Posterior pole color fundus photograph
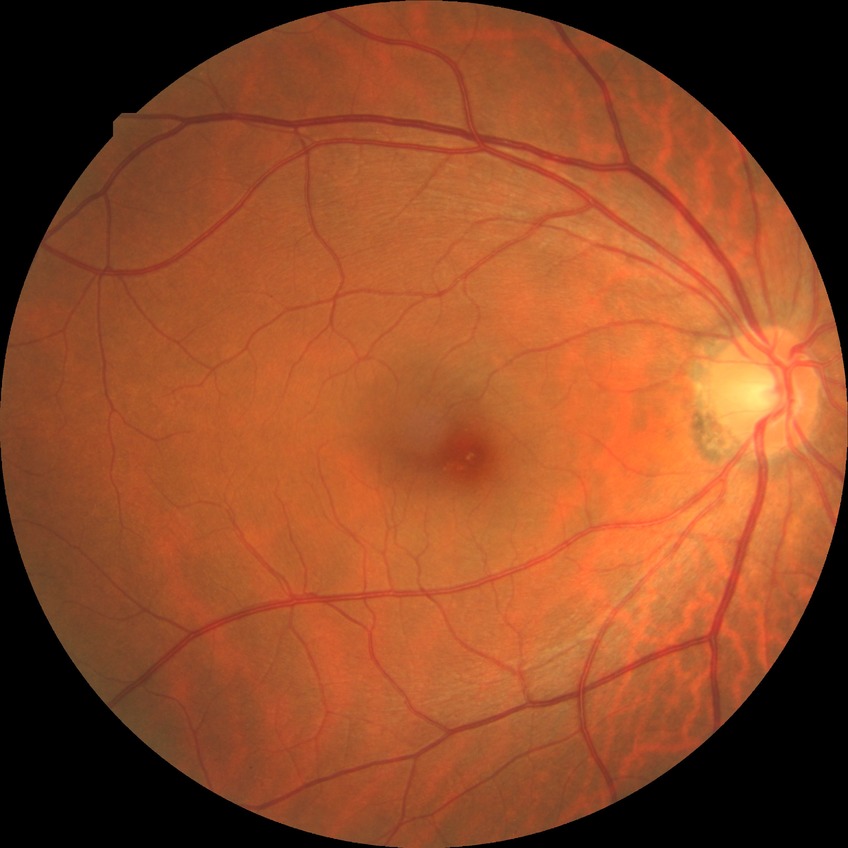 Diabetic retinopathy (DR) is NDR (no diabetic retinopathy).